Acquired on the Phoenix ICON · infant wide-field fundus photograph.
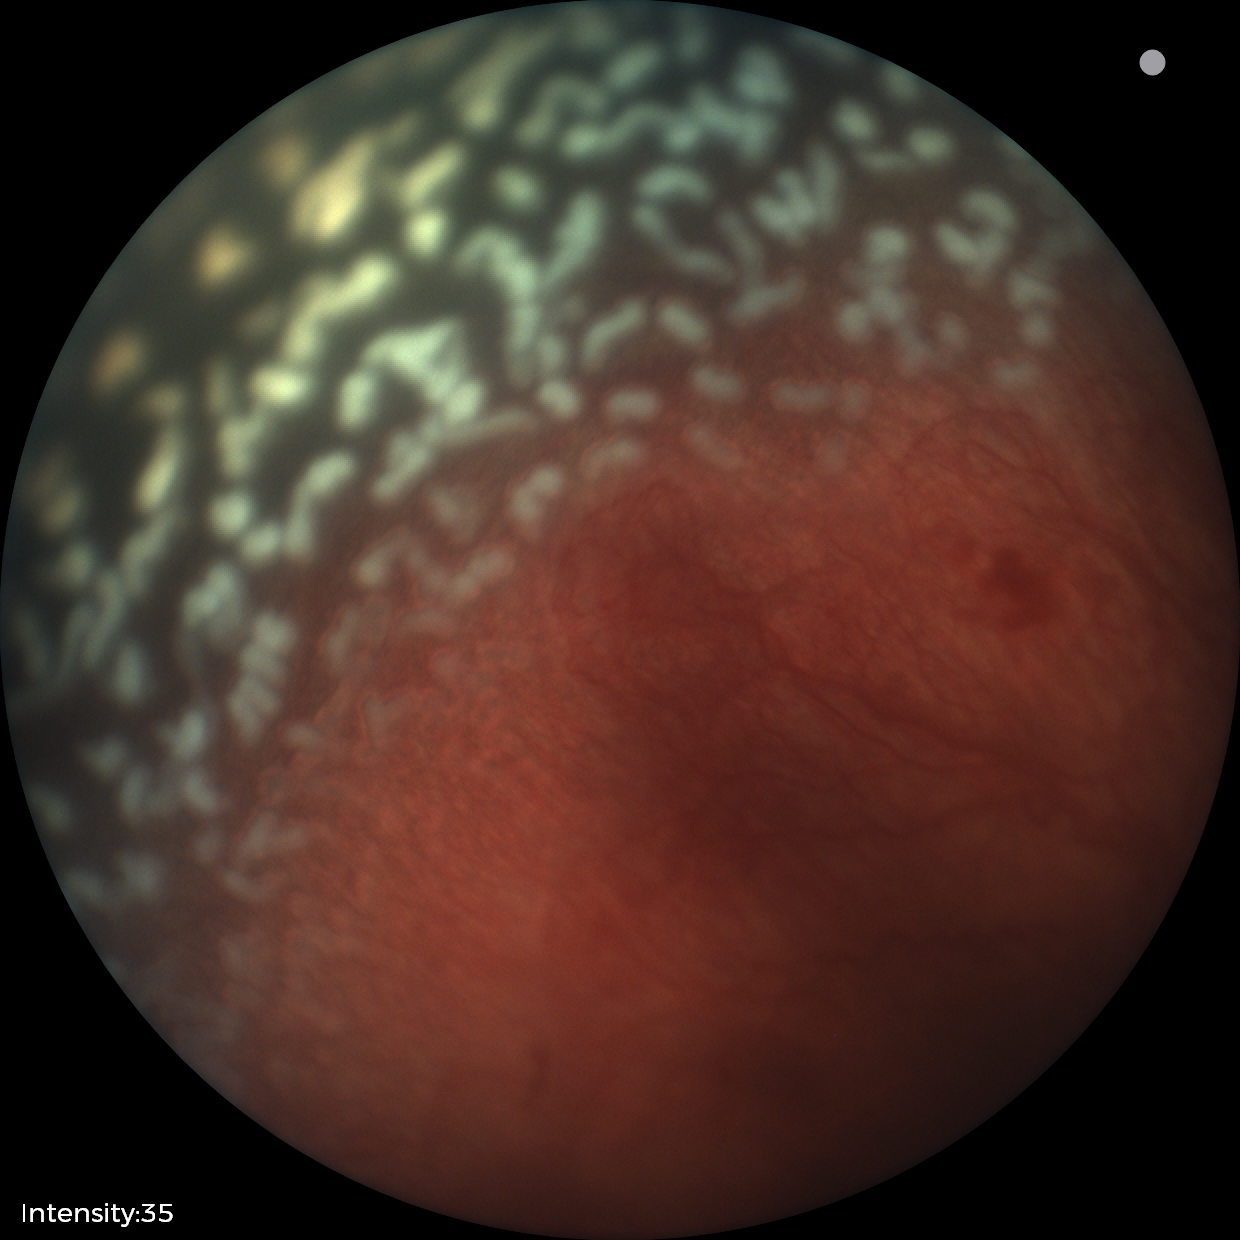 Finding = ROP stage 2 — ridge with height and width at the demarcation line
plus form = present